848 x 848 pixels · retinal fundus photograph · 45 degree fundus photograph · camera: NIDEK AFC-230
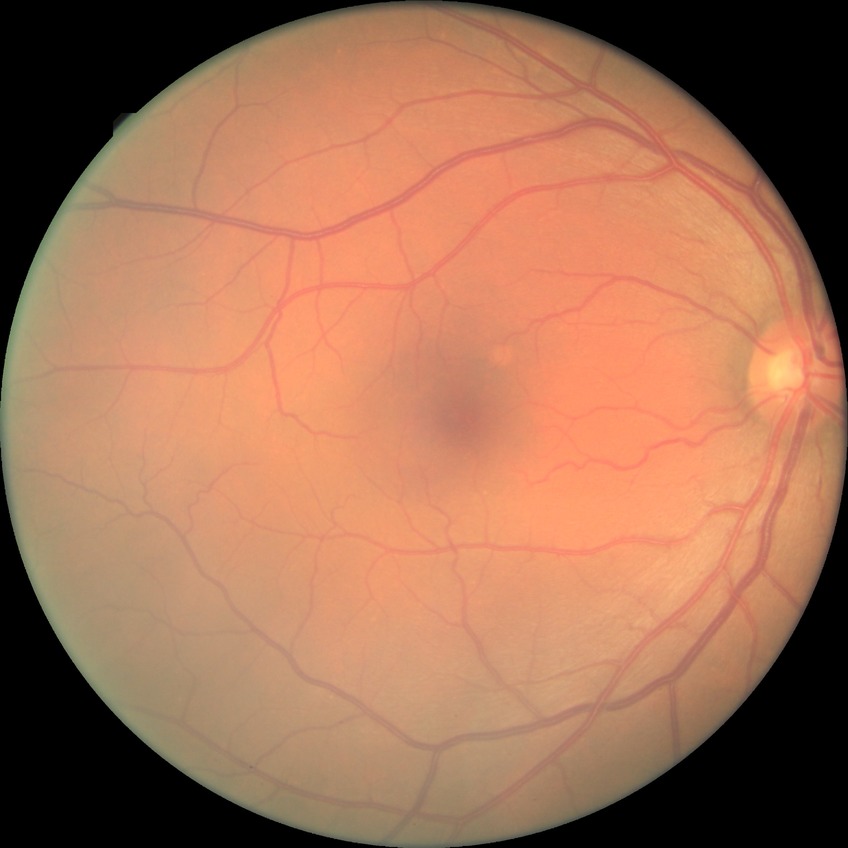

DR stage@NDR.